Color fundus photograph; pupil-dilated: 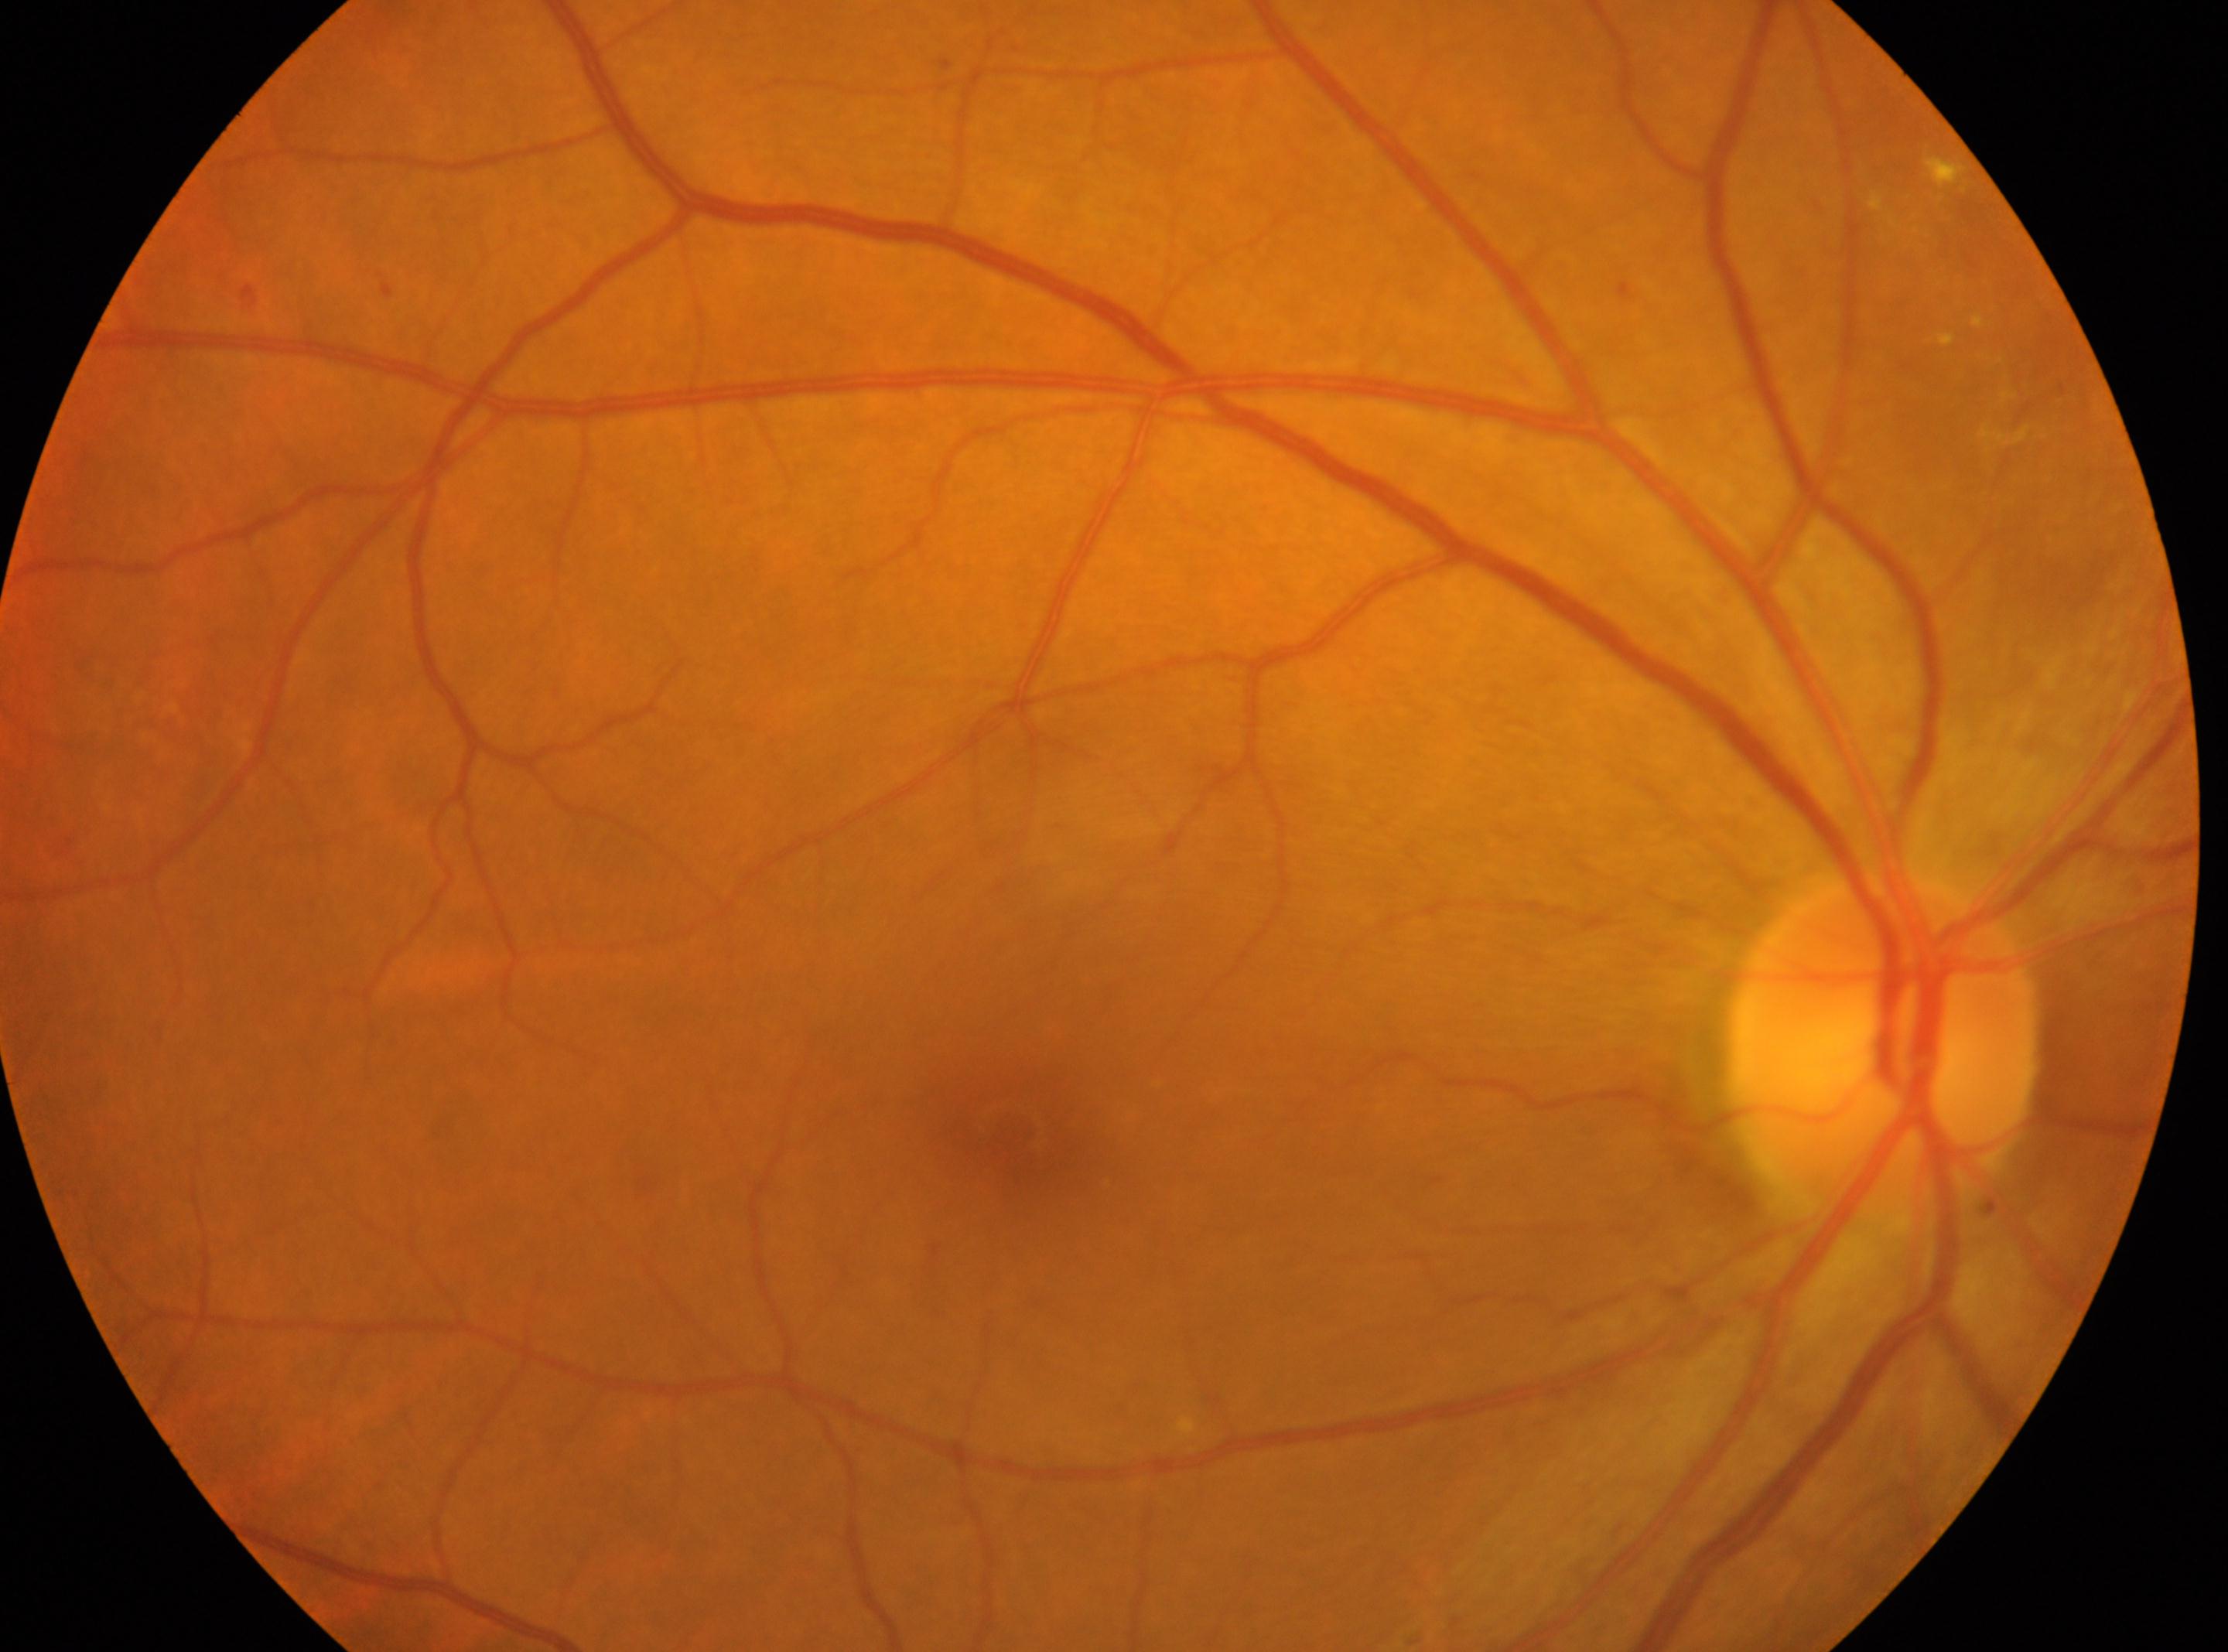

{"fovea": "x=1024, y=1126", "eye": "oculus dexter", "optic_disc": "x=1881, y=1047", "dr_category": "non-proliferative diabetic retinopathy", "dr_grade": "2"}